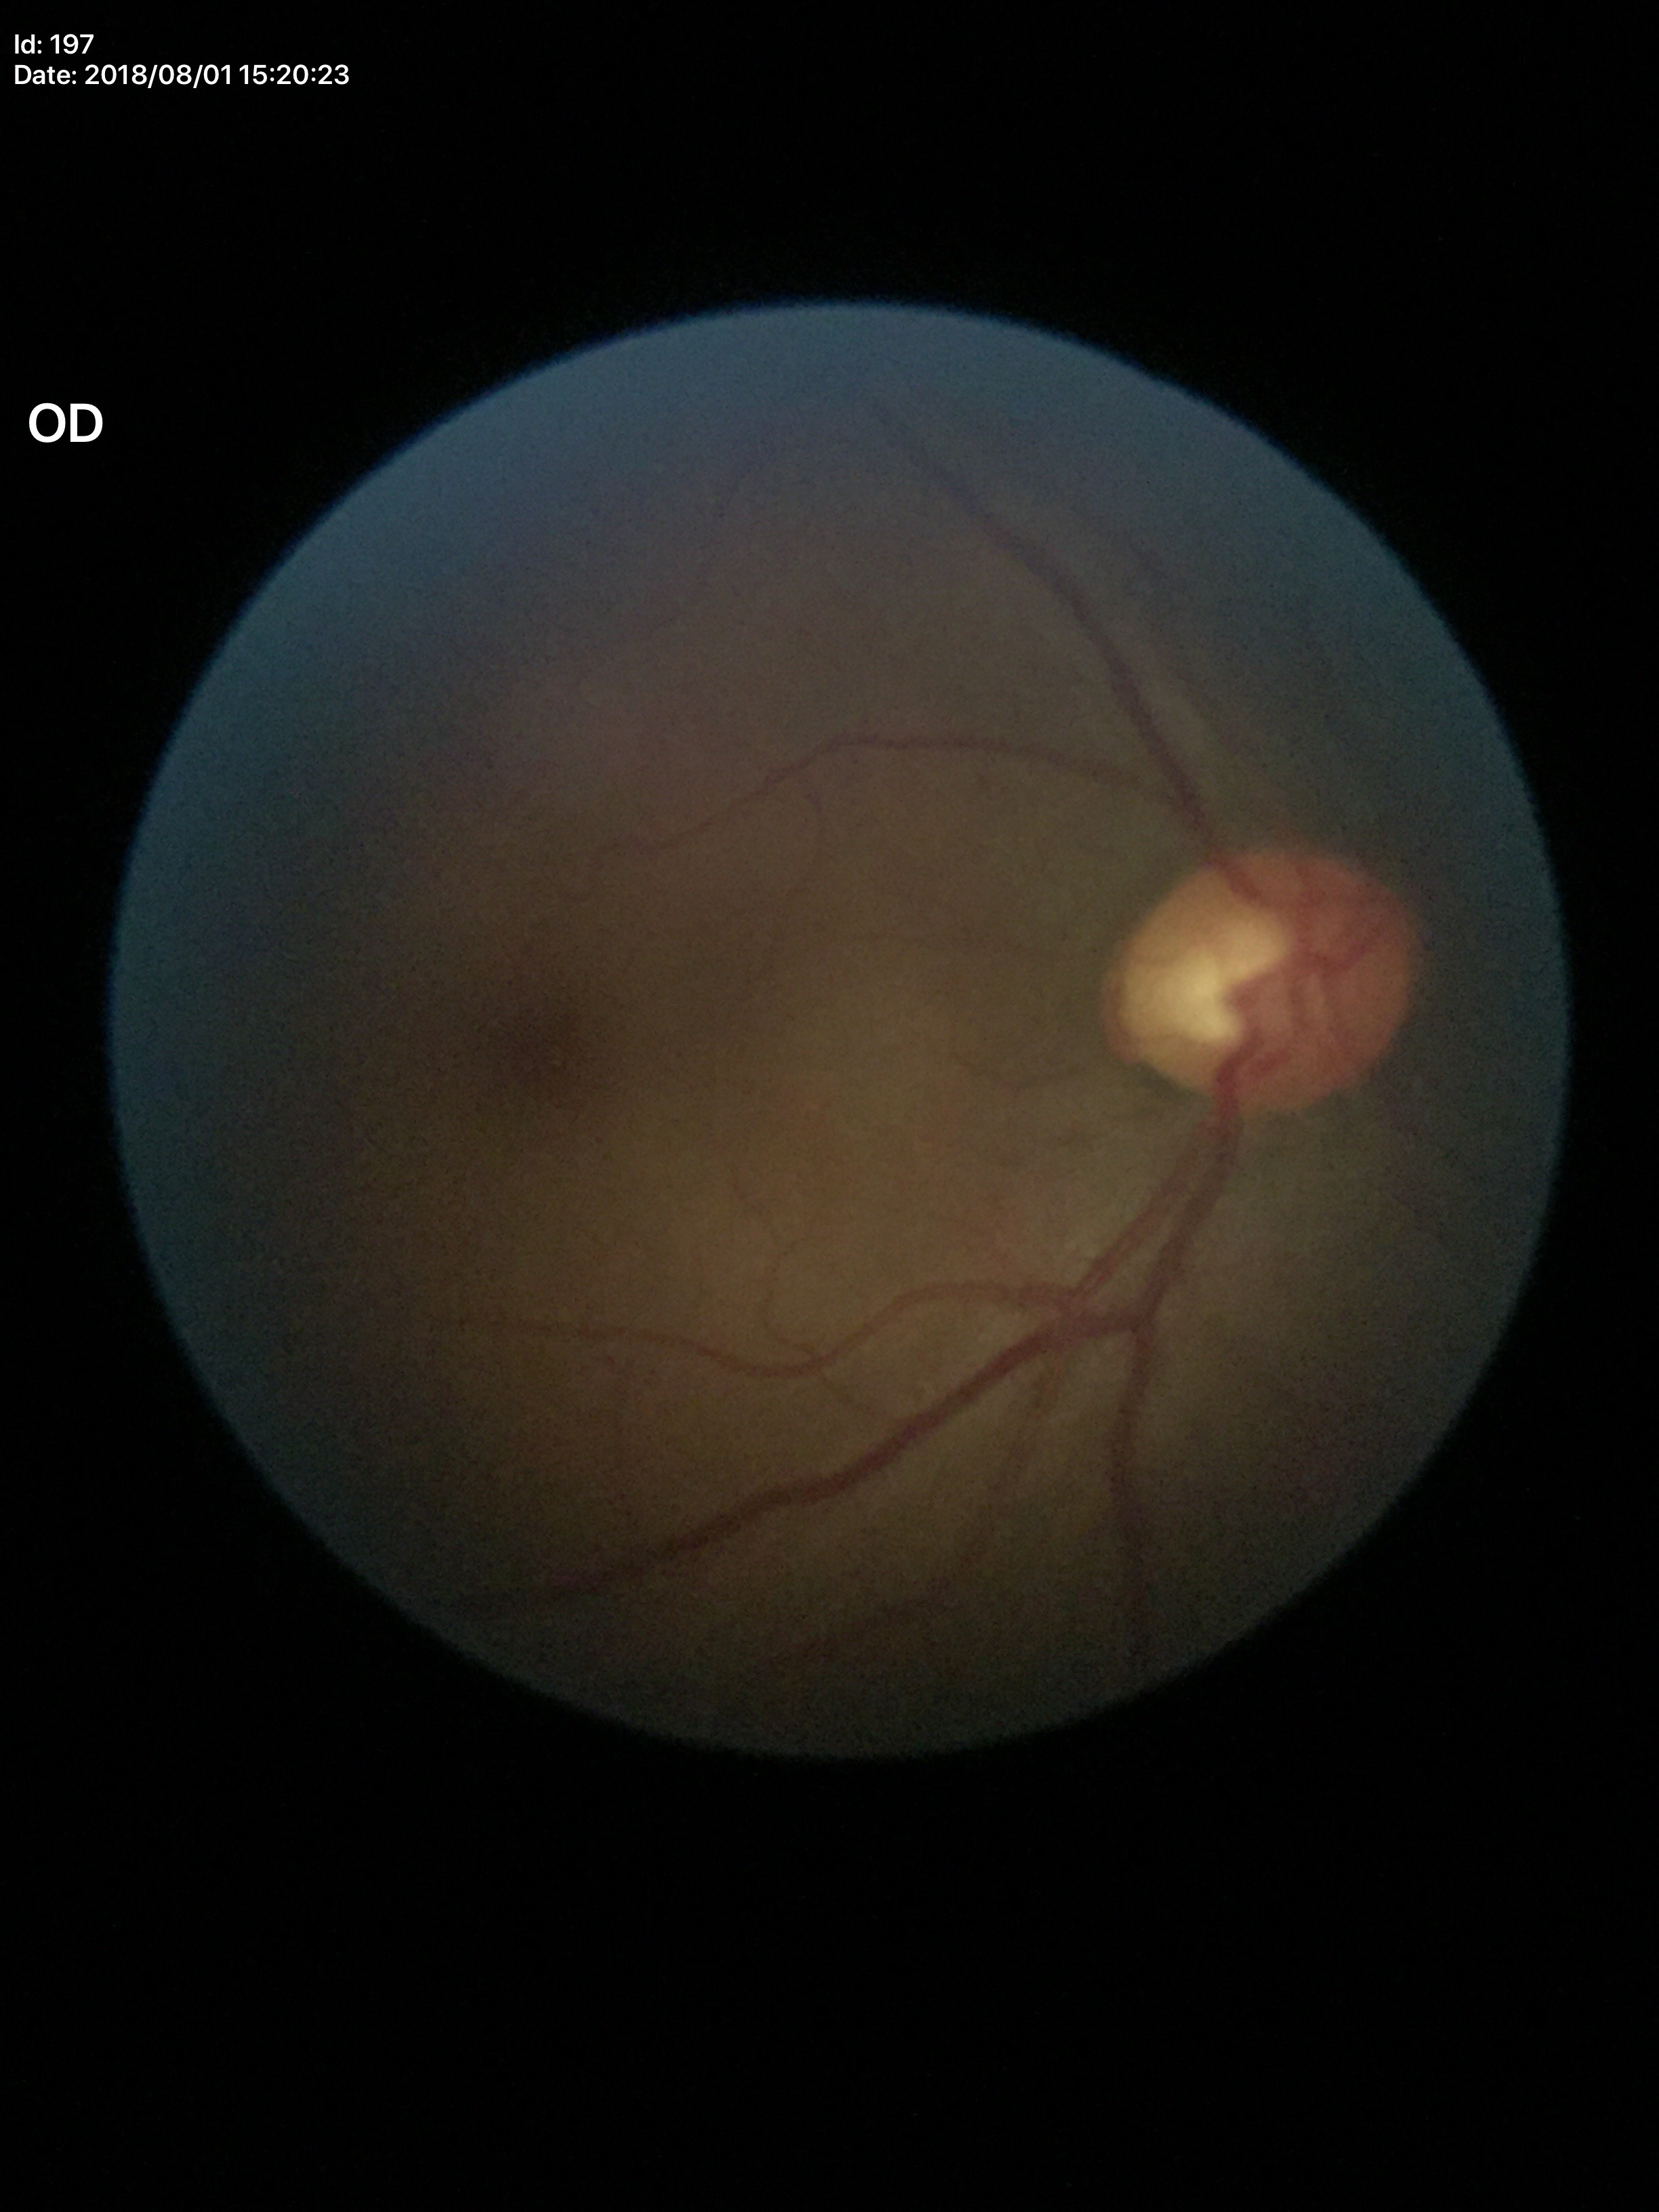

* vertical cup-to-disc ratio — 0.57
* Glaucoma assessment — negative